1504x1000px. Fundus photo: 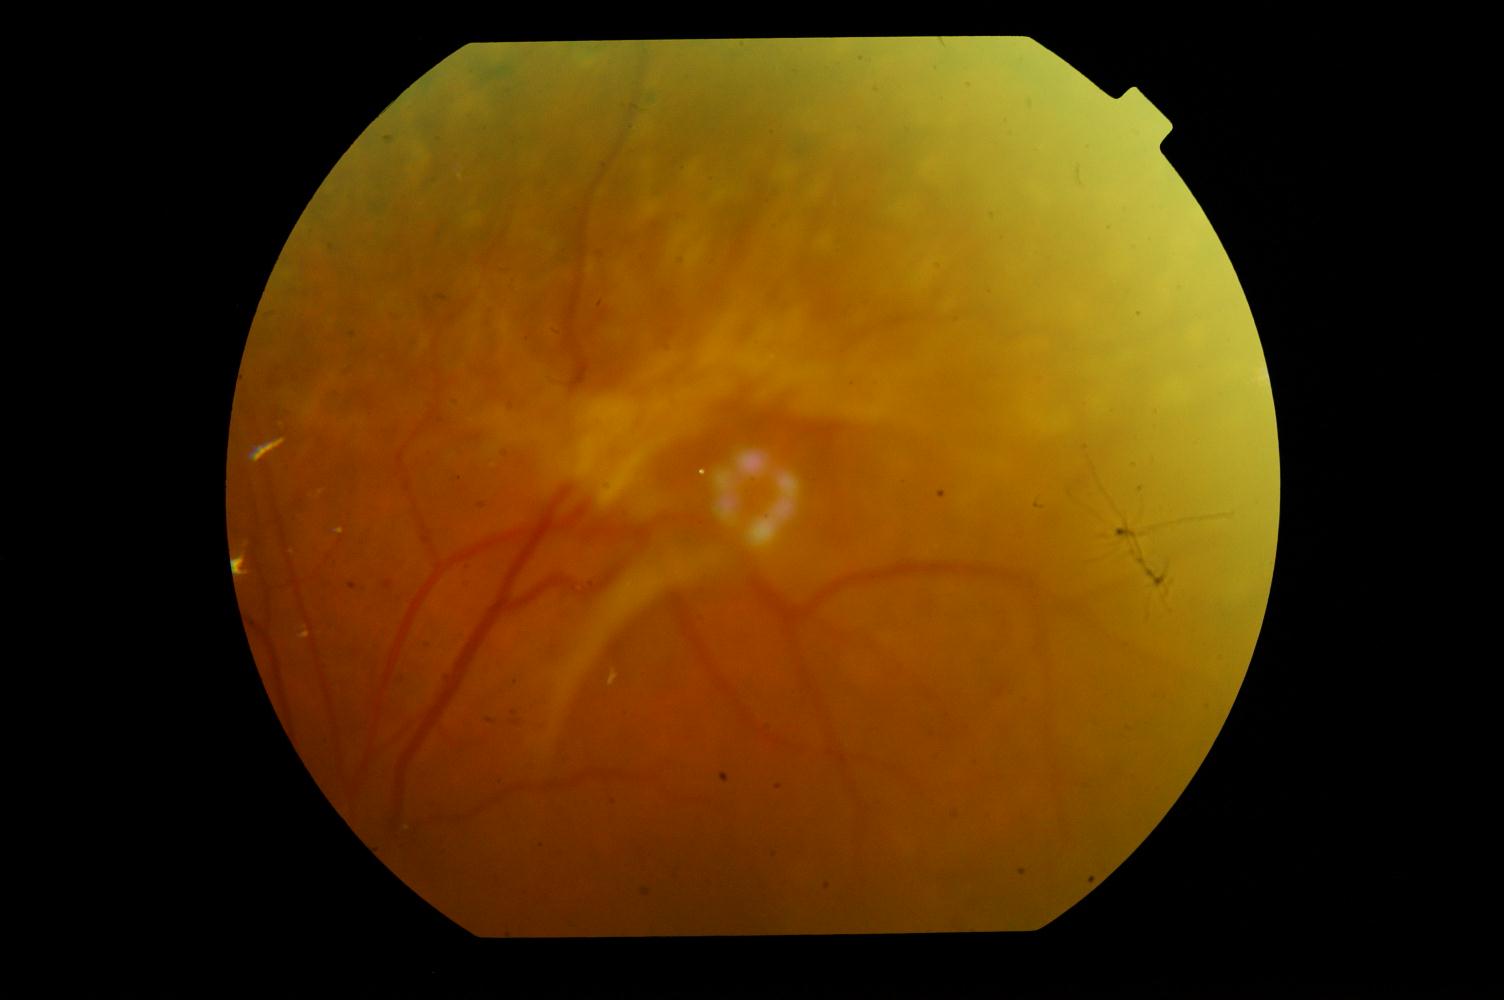 There is evidence of diabetic retinopathy.